CFP
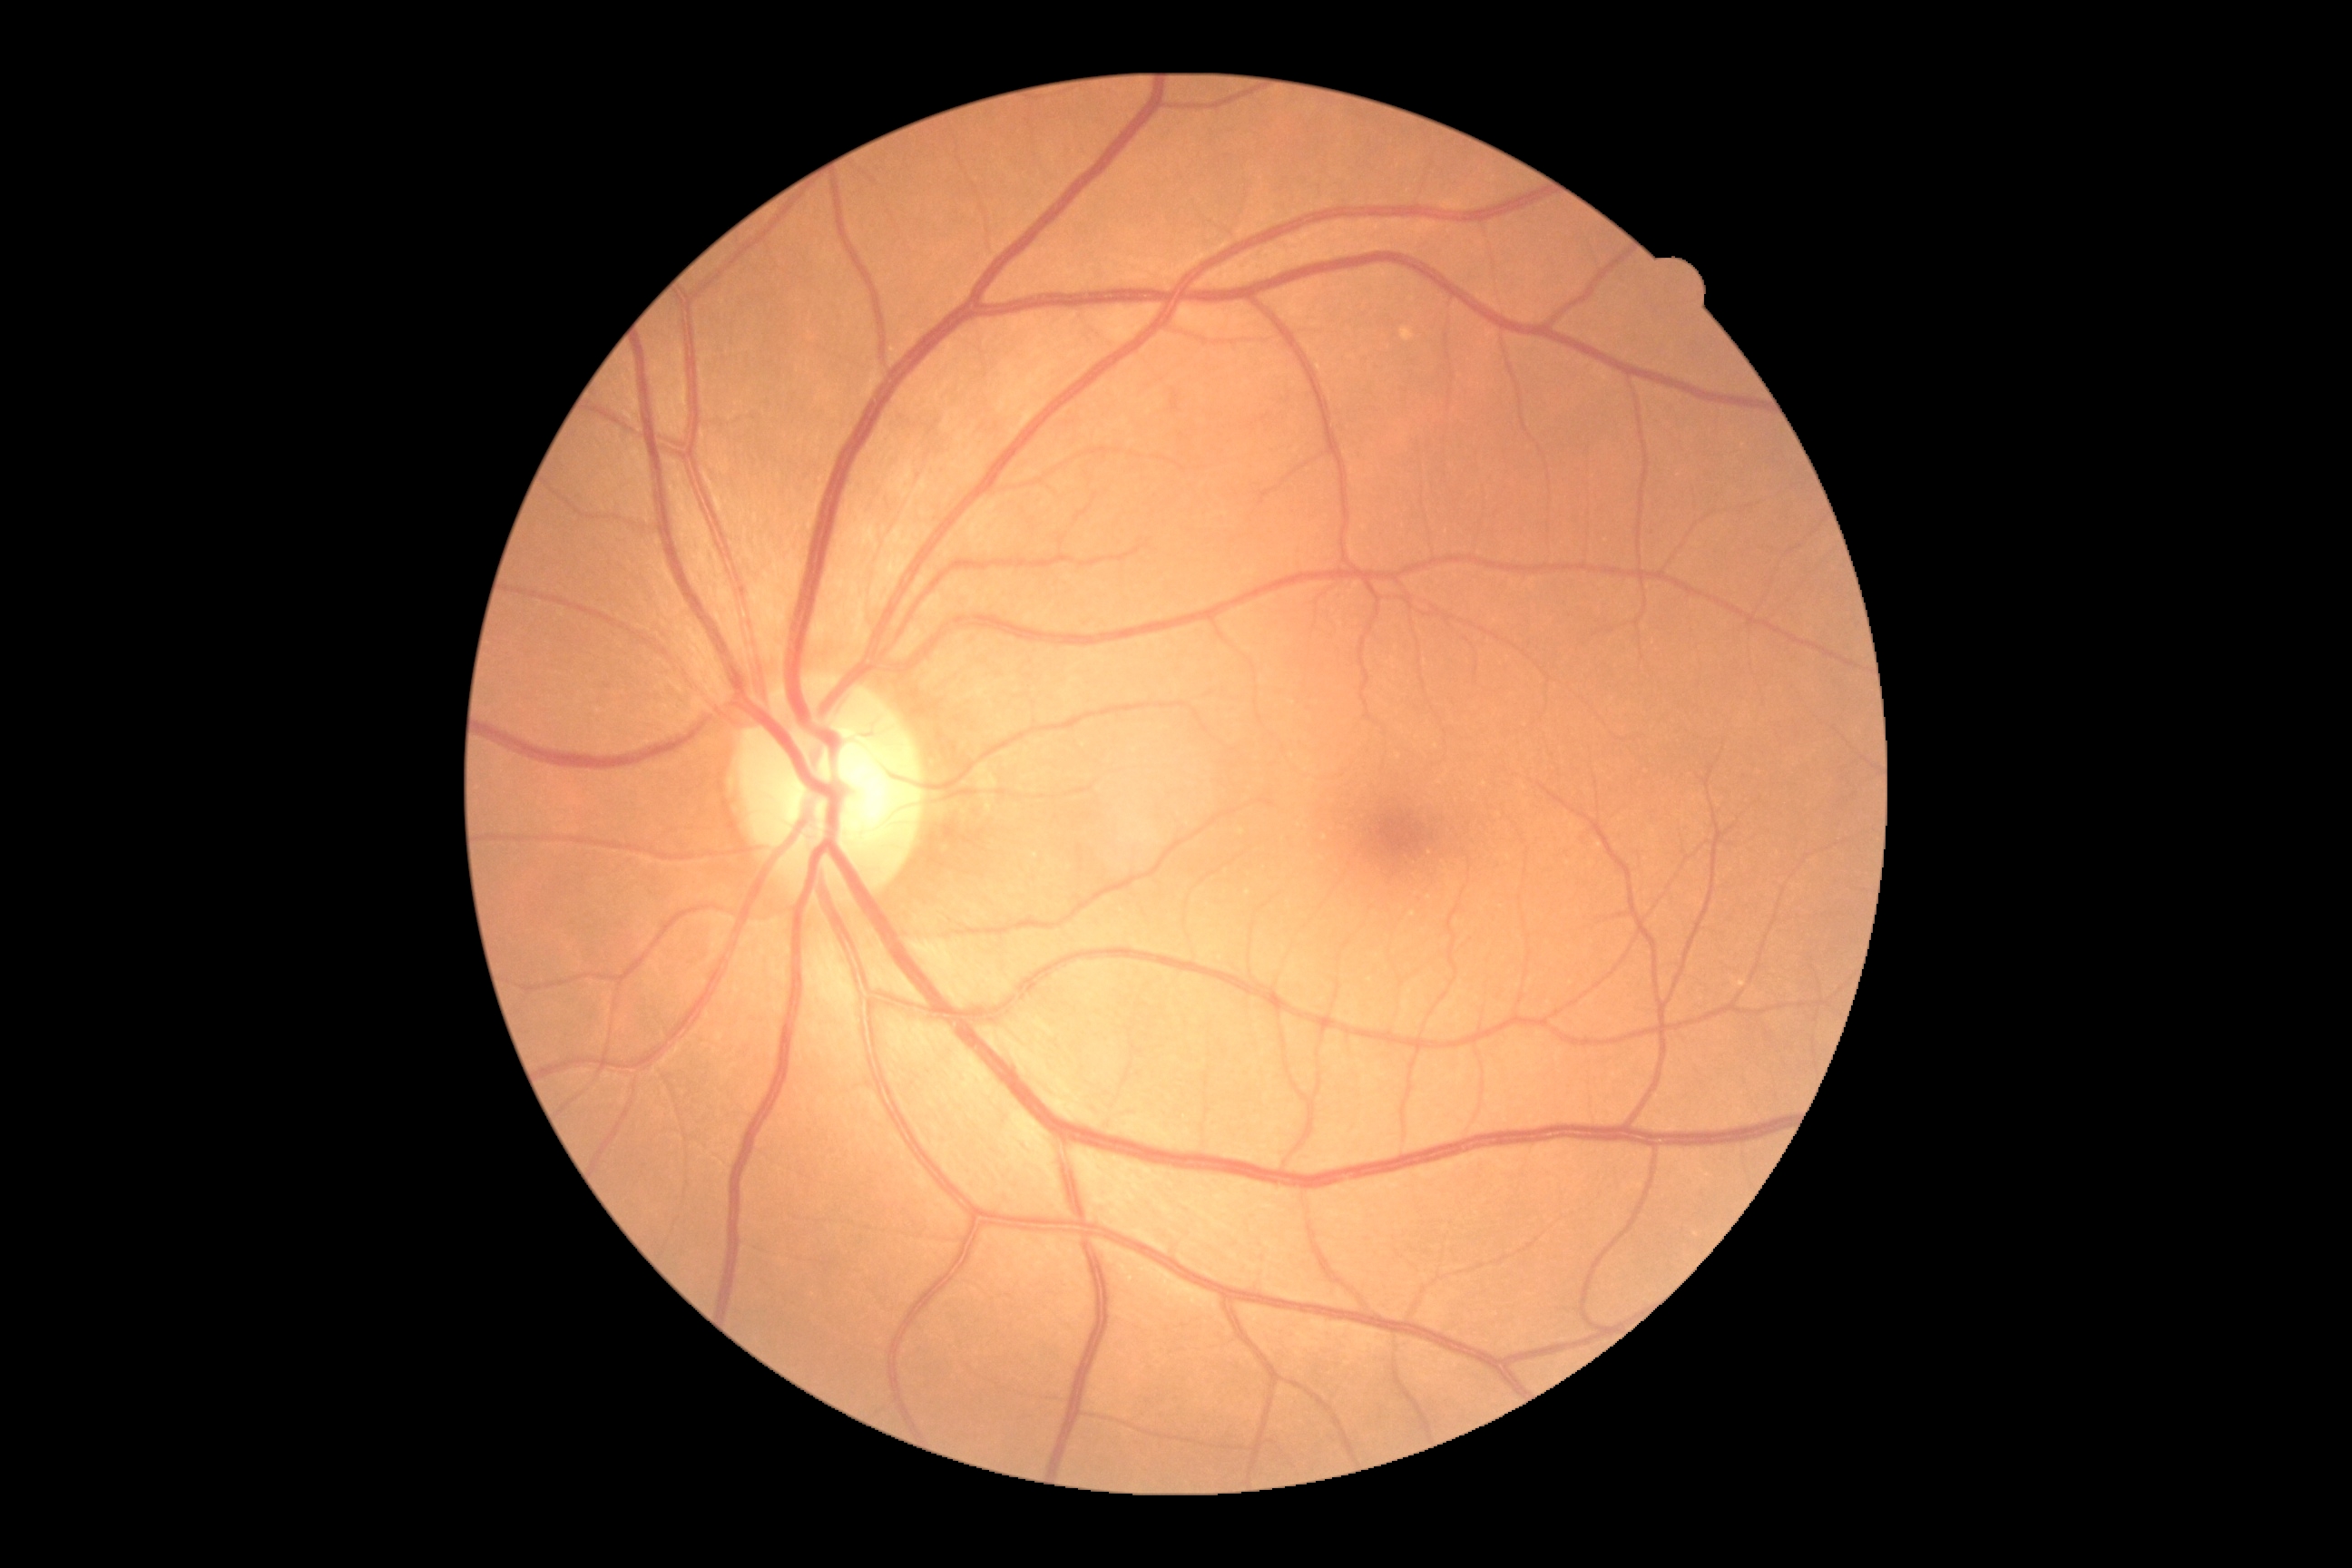
• DR grade: 0/4
• DR impression: no apparent DR